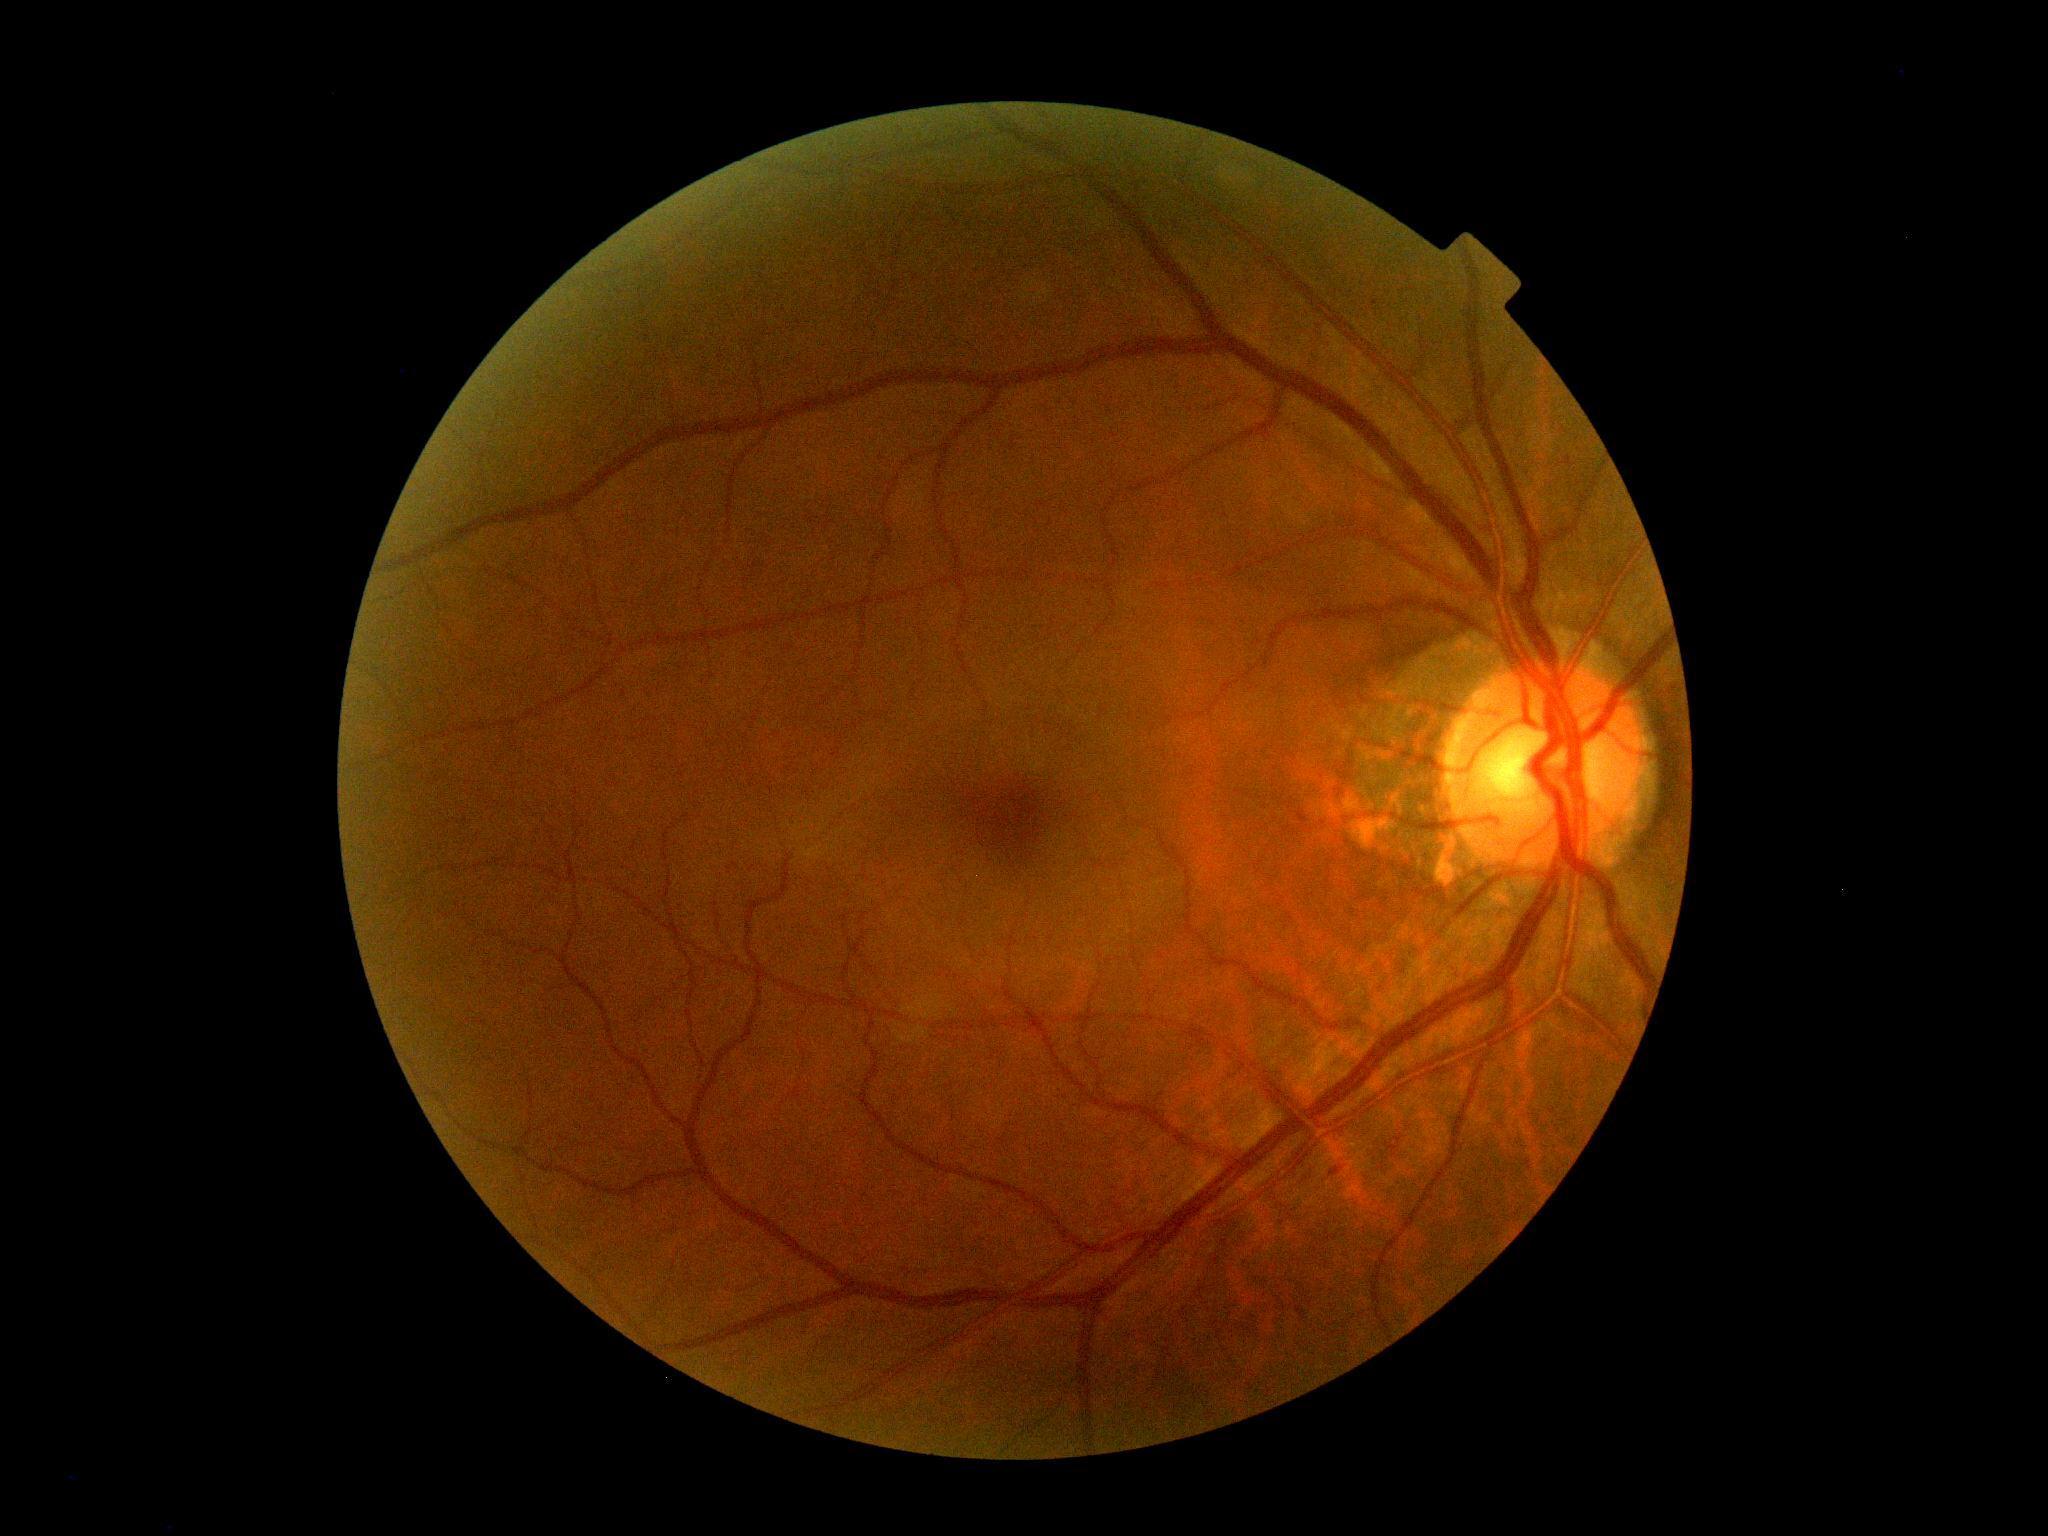 Diabetic retinopathy severity is no apparent retinopathy (grade 0).